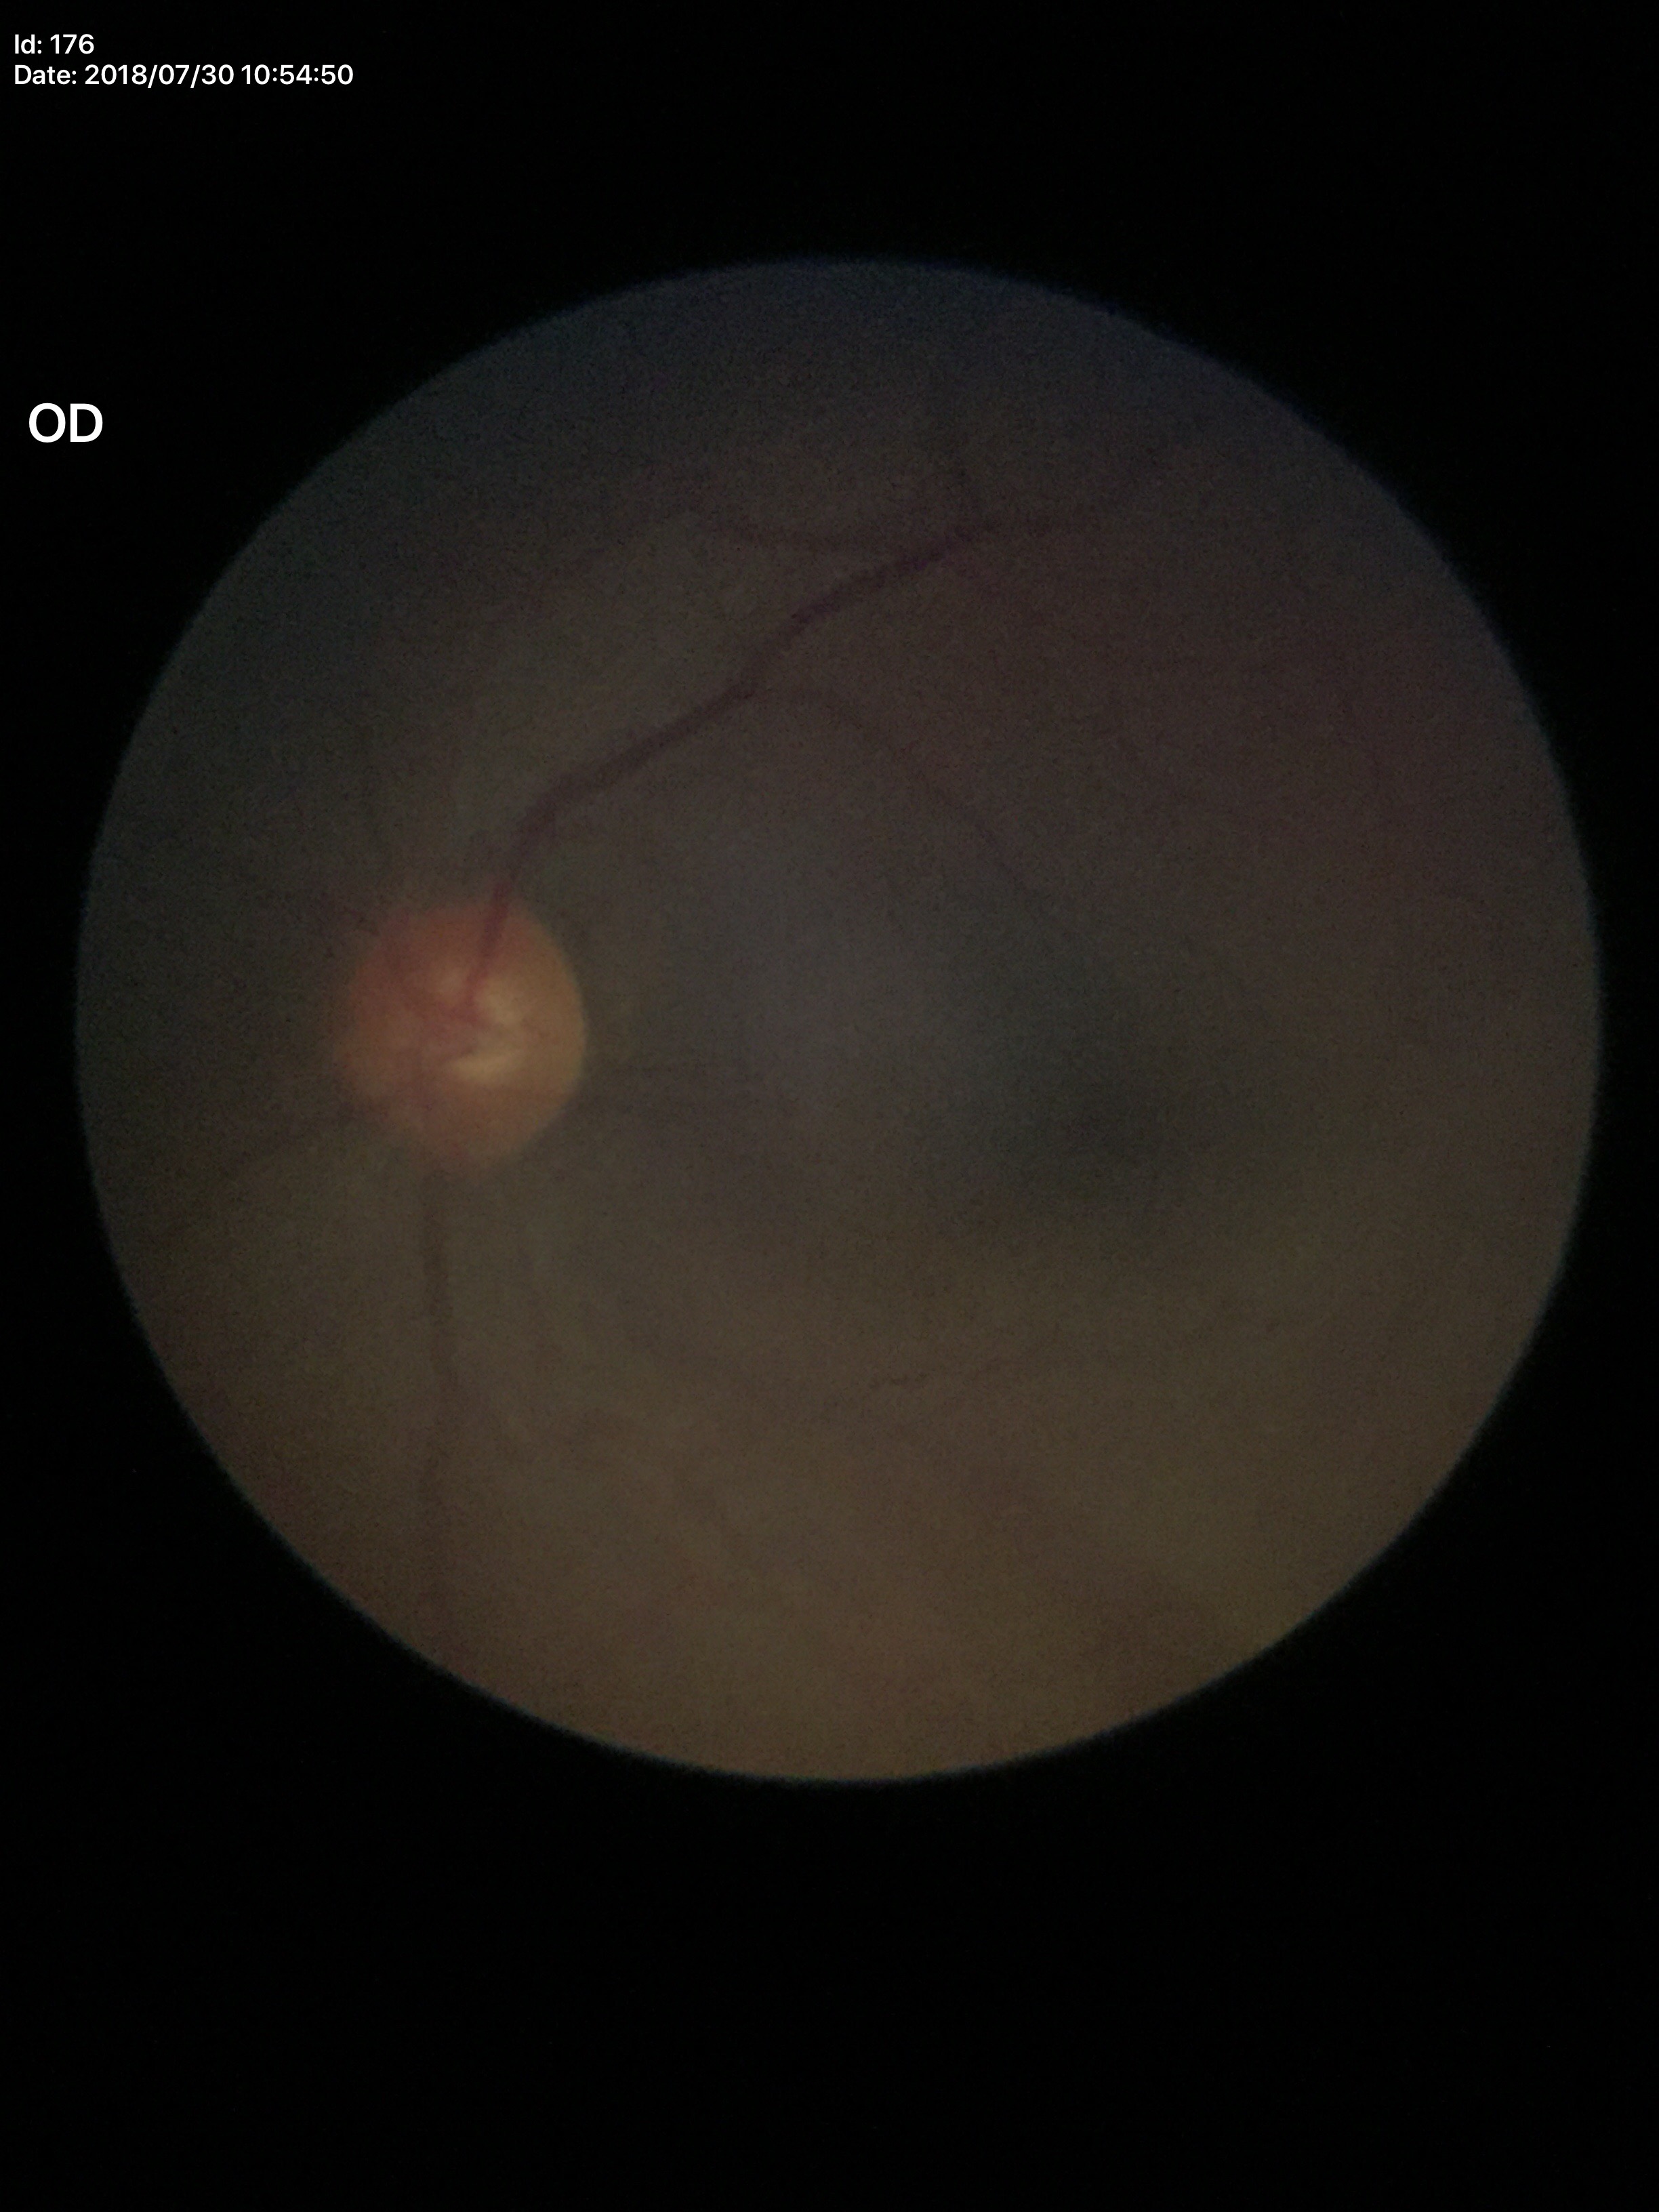

Vertical CDR (VCDR) of 0.50. Glaucoma screening: negative (5/5 ophthalmologists in agreement).